848 by 848 pixels, CFP, nonmydriatic, acquired with a NIDEK AFC-230, modified Davis classification
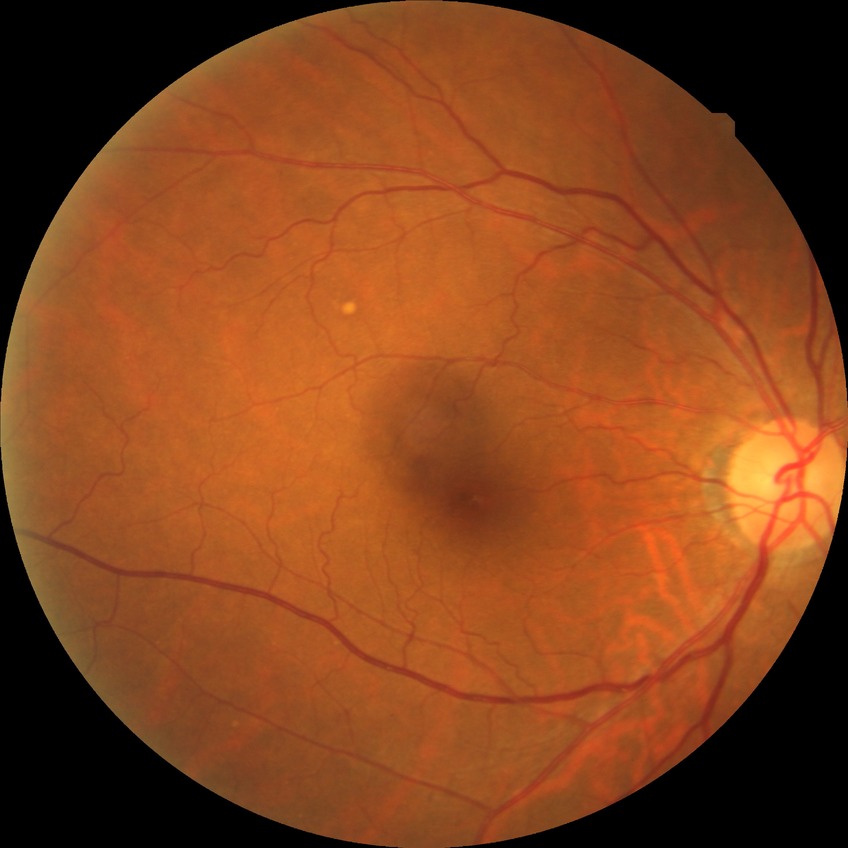

retinopathy stage=no diabetic retinopathy.